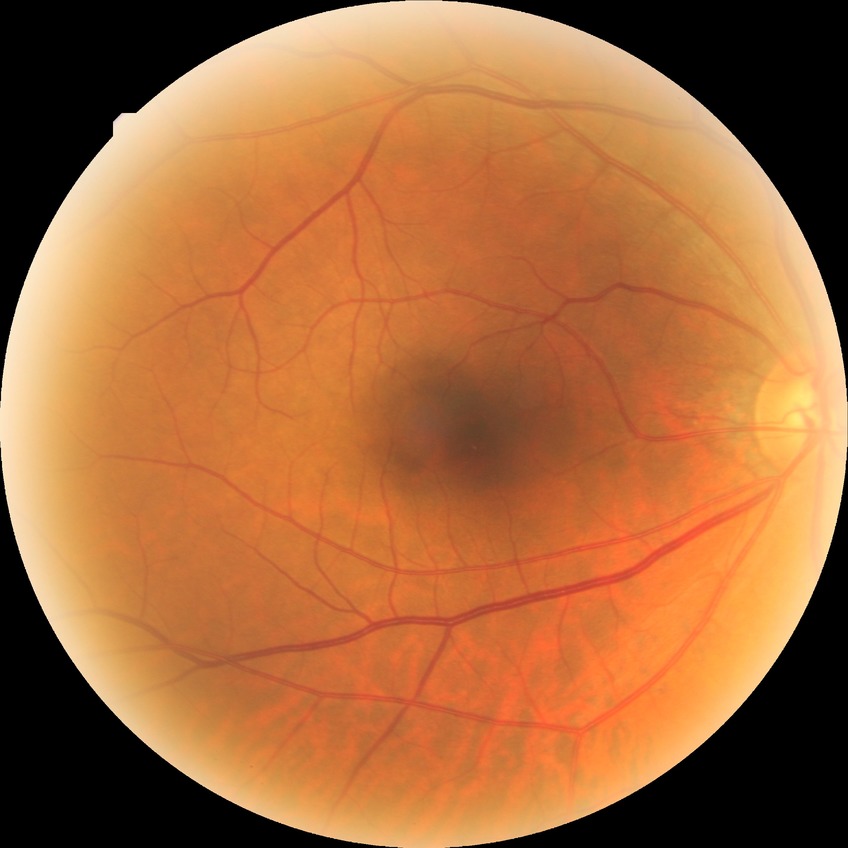
DR grade is NDR.